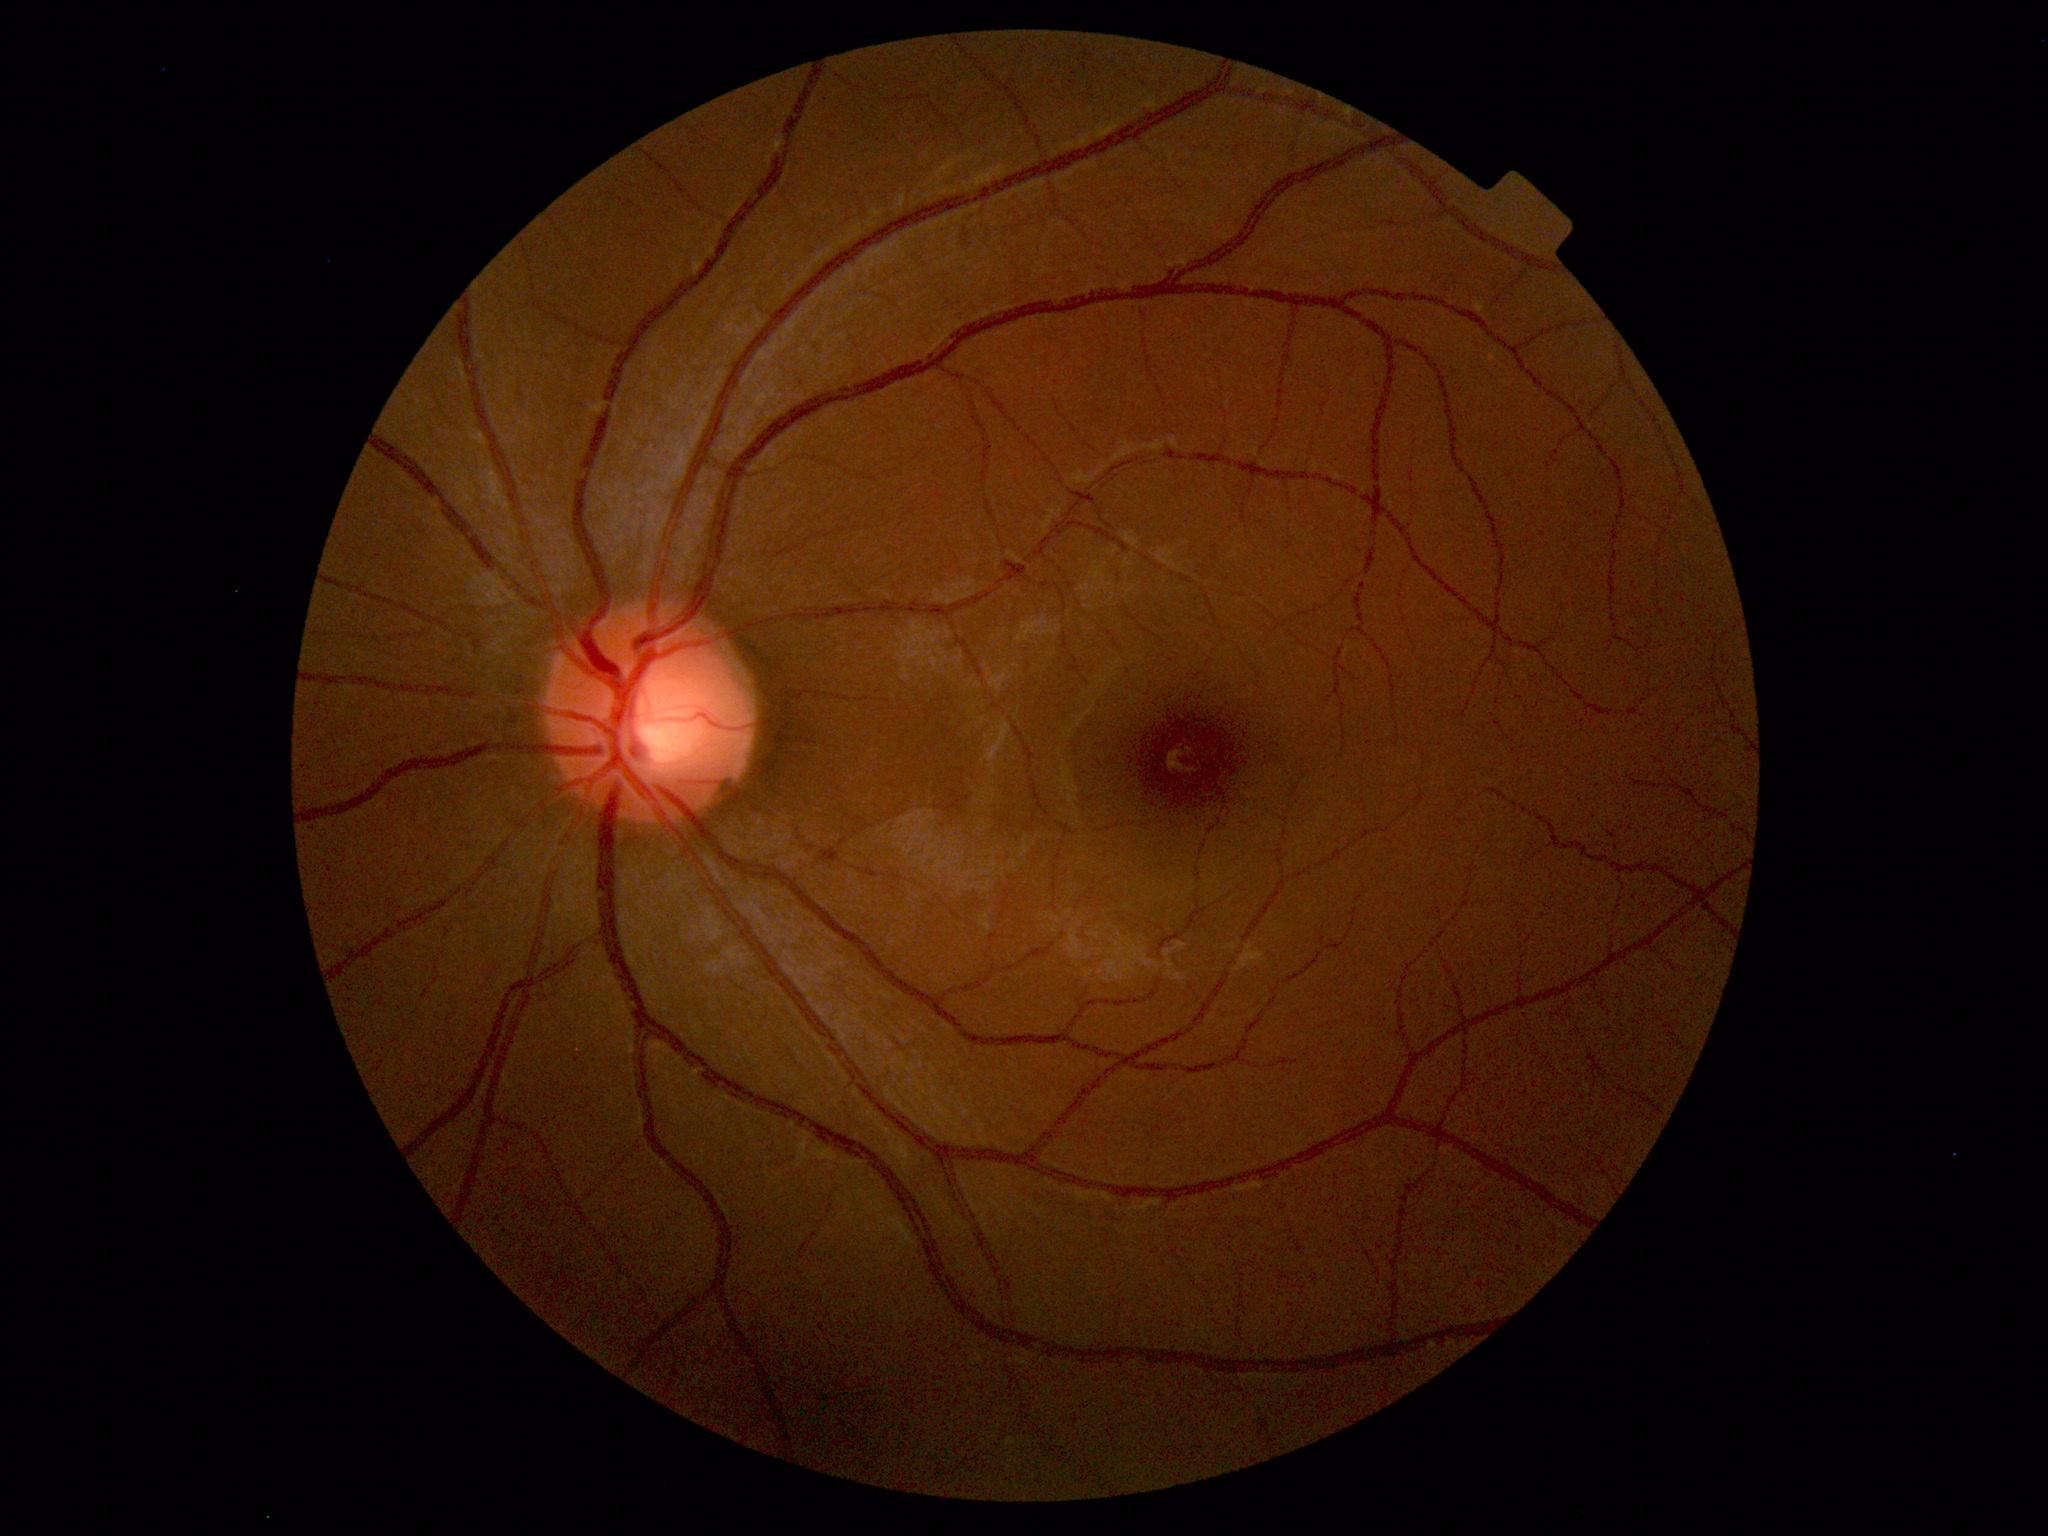

Within normal limits. No abnormalities identified.